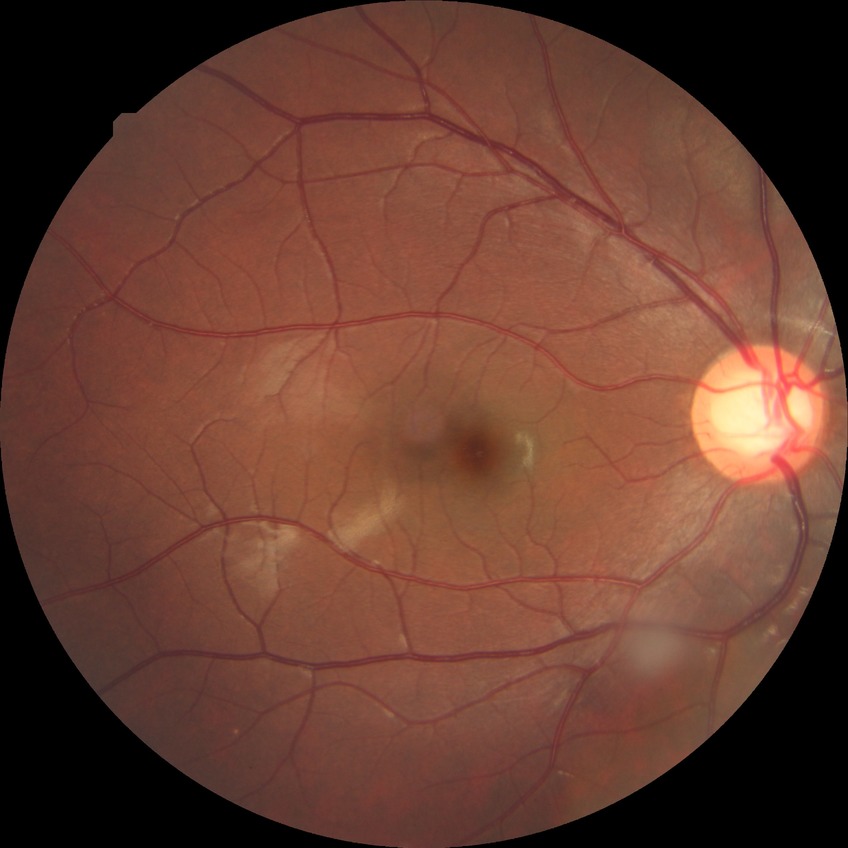
Diabetic retinopathy (DR): NDR (no diabetic retinopathy).